640x480 · acquired on the Clarity RetCam 3 · wide-field fundus photograph of an infant:
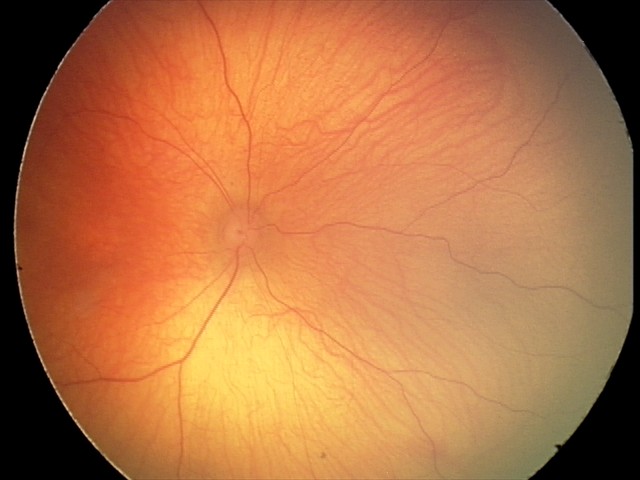
Examination with physiological retinal findings.